2352x1568
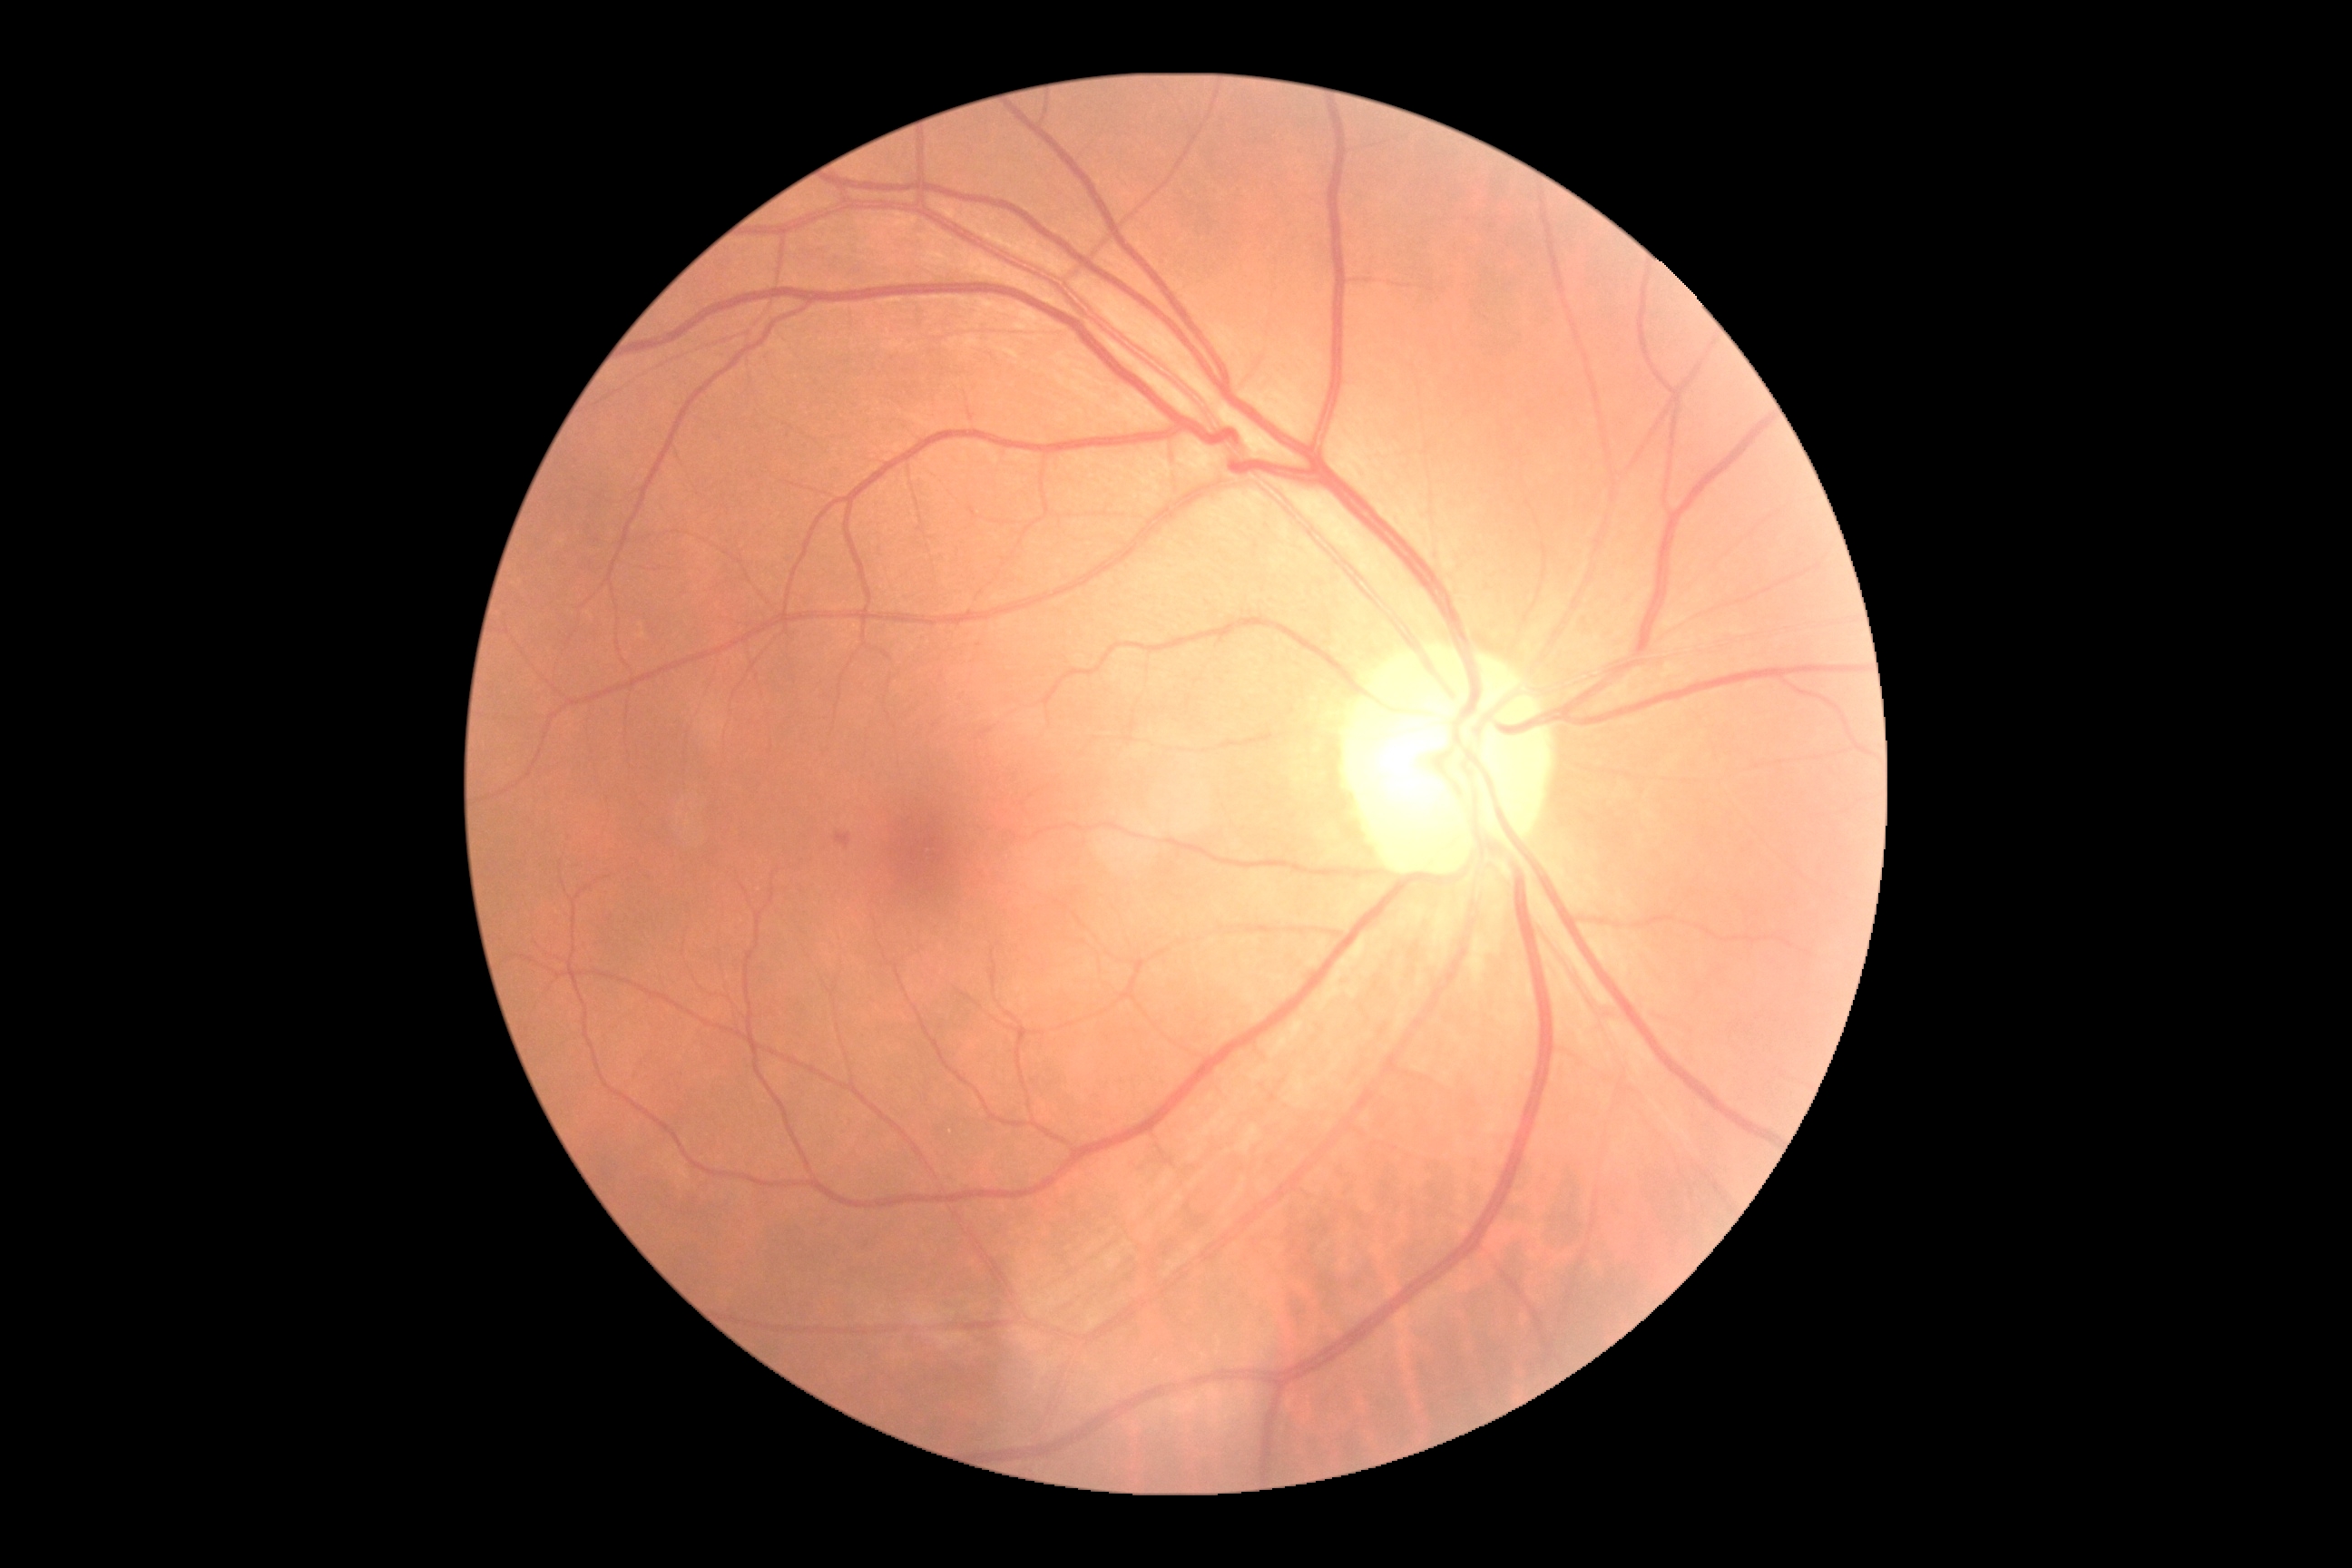 diabetic retinopathy (DR)=grade 2.